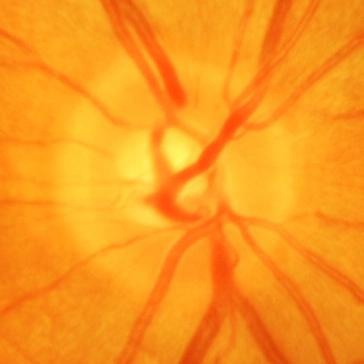 Glaucomatous changes are present. Disc-centered fundus crop showing glaucomatous damage to the optic nerve.